2352 by 1568 pixels, 45-degree field of view.
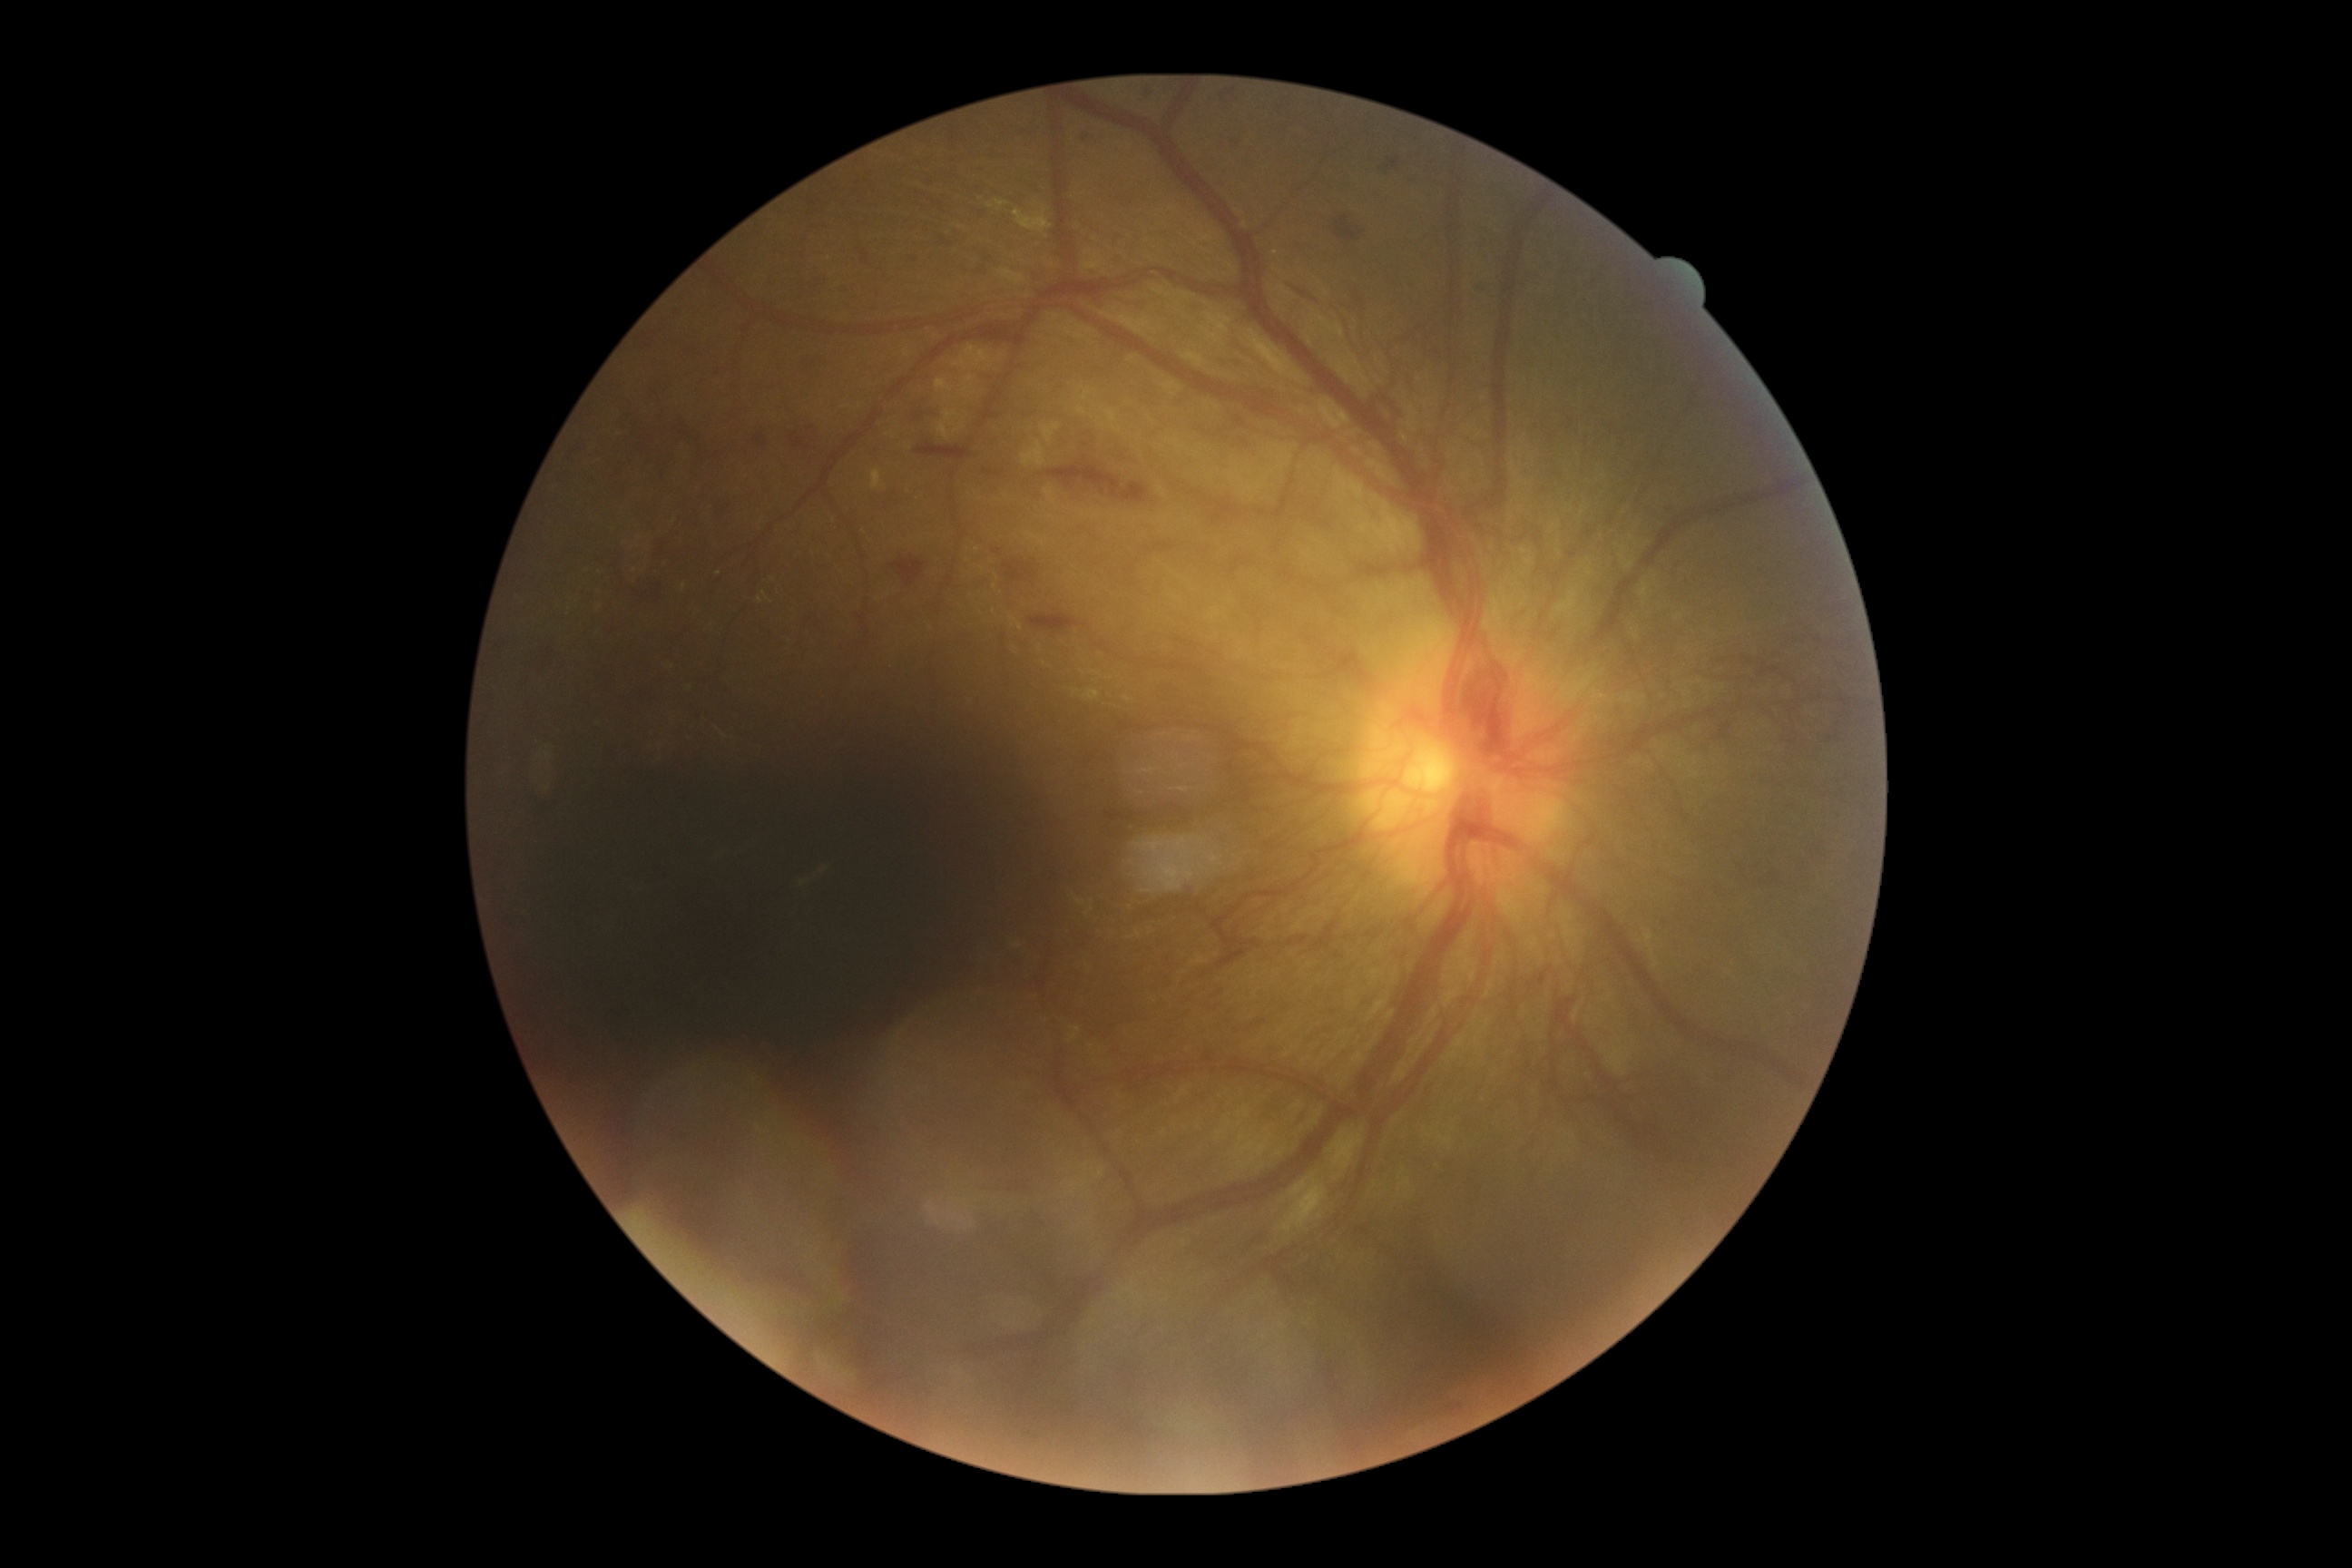

Diabetic retinopathy (DR): grade 4 (PDR).